45-degree field of view; no pharmacologic dilation; 848 by 848 pixels
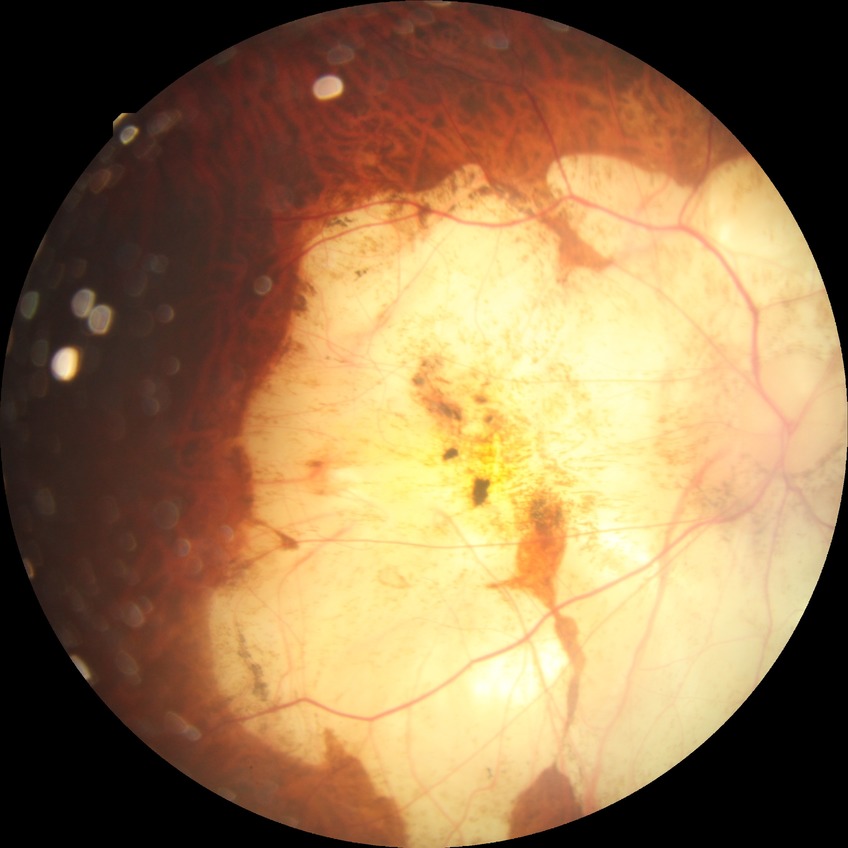
Modified Davis classification: no diabetic retinopathy.